FOV: 45 degrees:
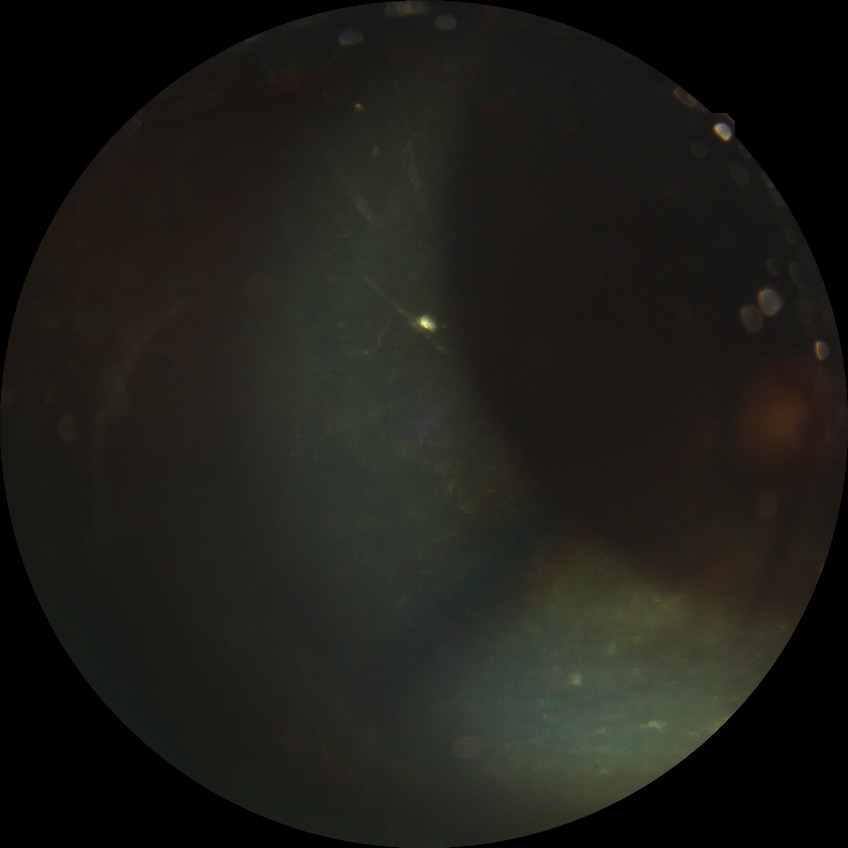 Diabetic retinopathy (DR) is proliferative diabetic retinopathy (PDR).